Nonmydriatic. 848x848px. Modified Davis classification. Camera: NIDEK AFC-230. 45-degree field of view
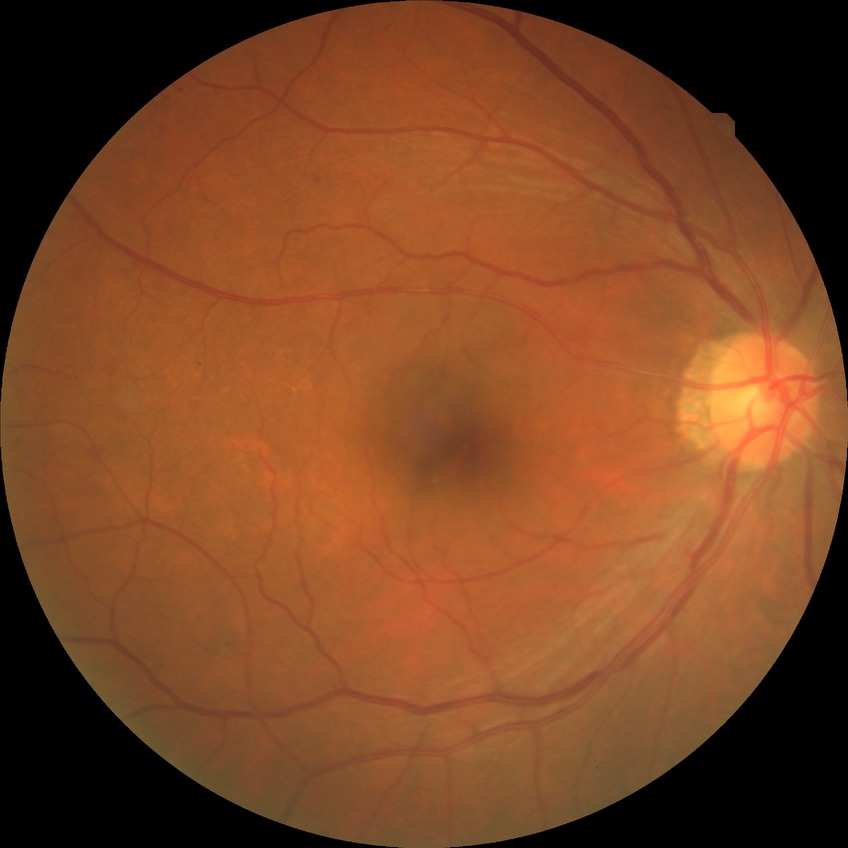

Modified Davis classification: simple diabetic retinopathy. Disease class: non-proliferative diabetic retinopathy.